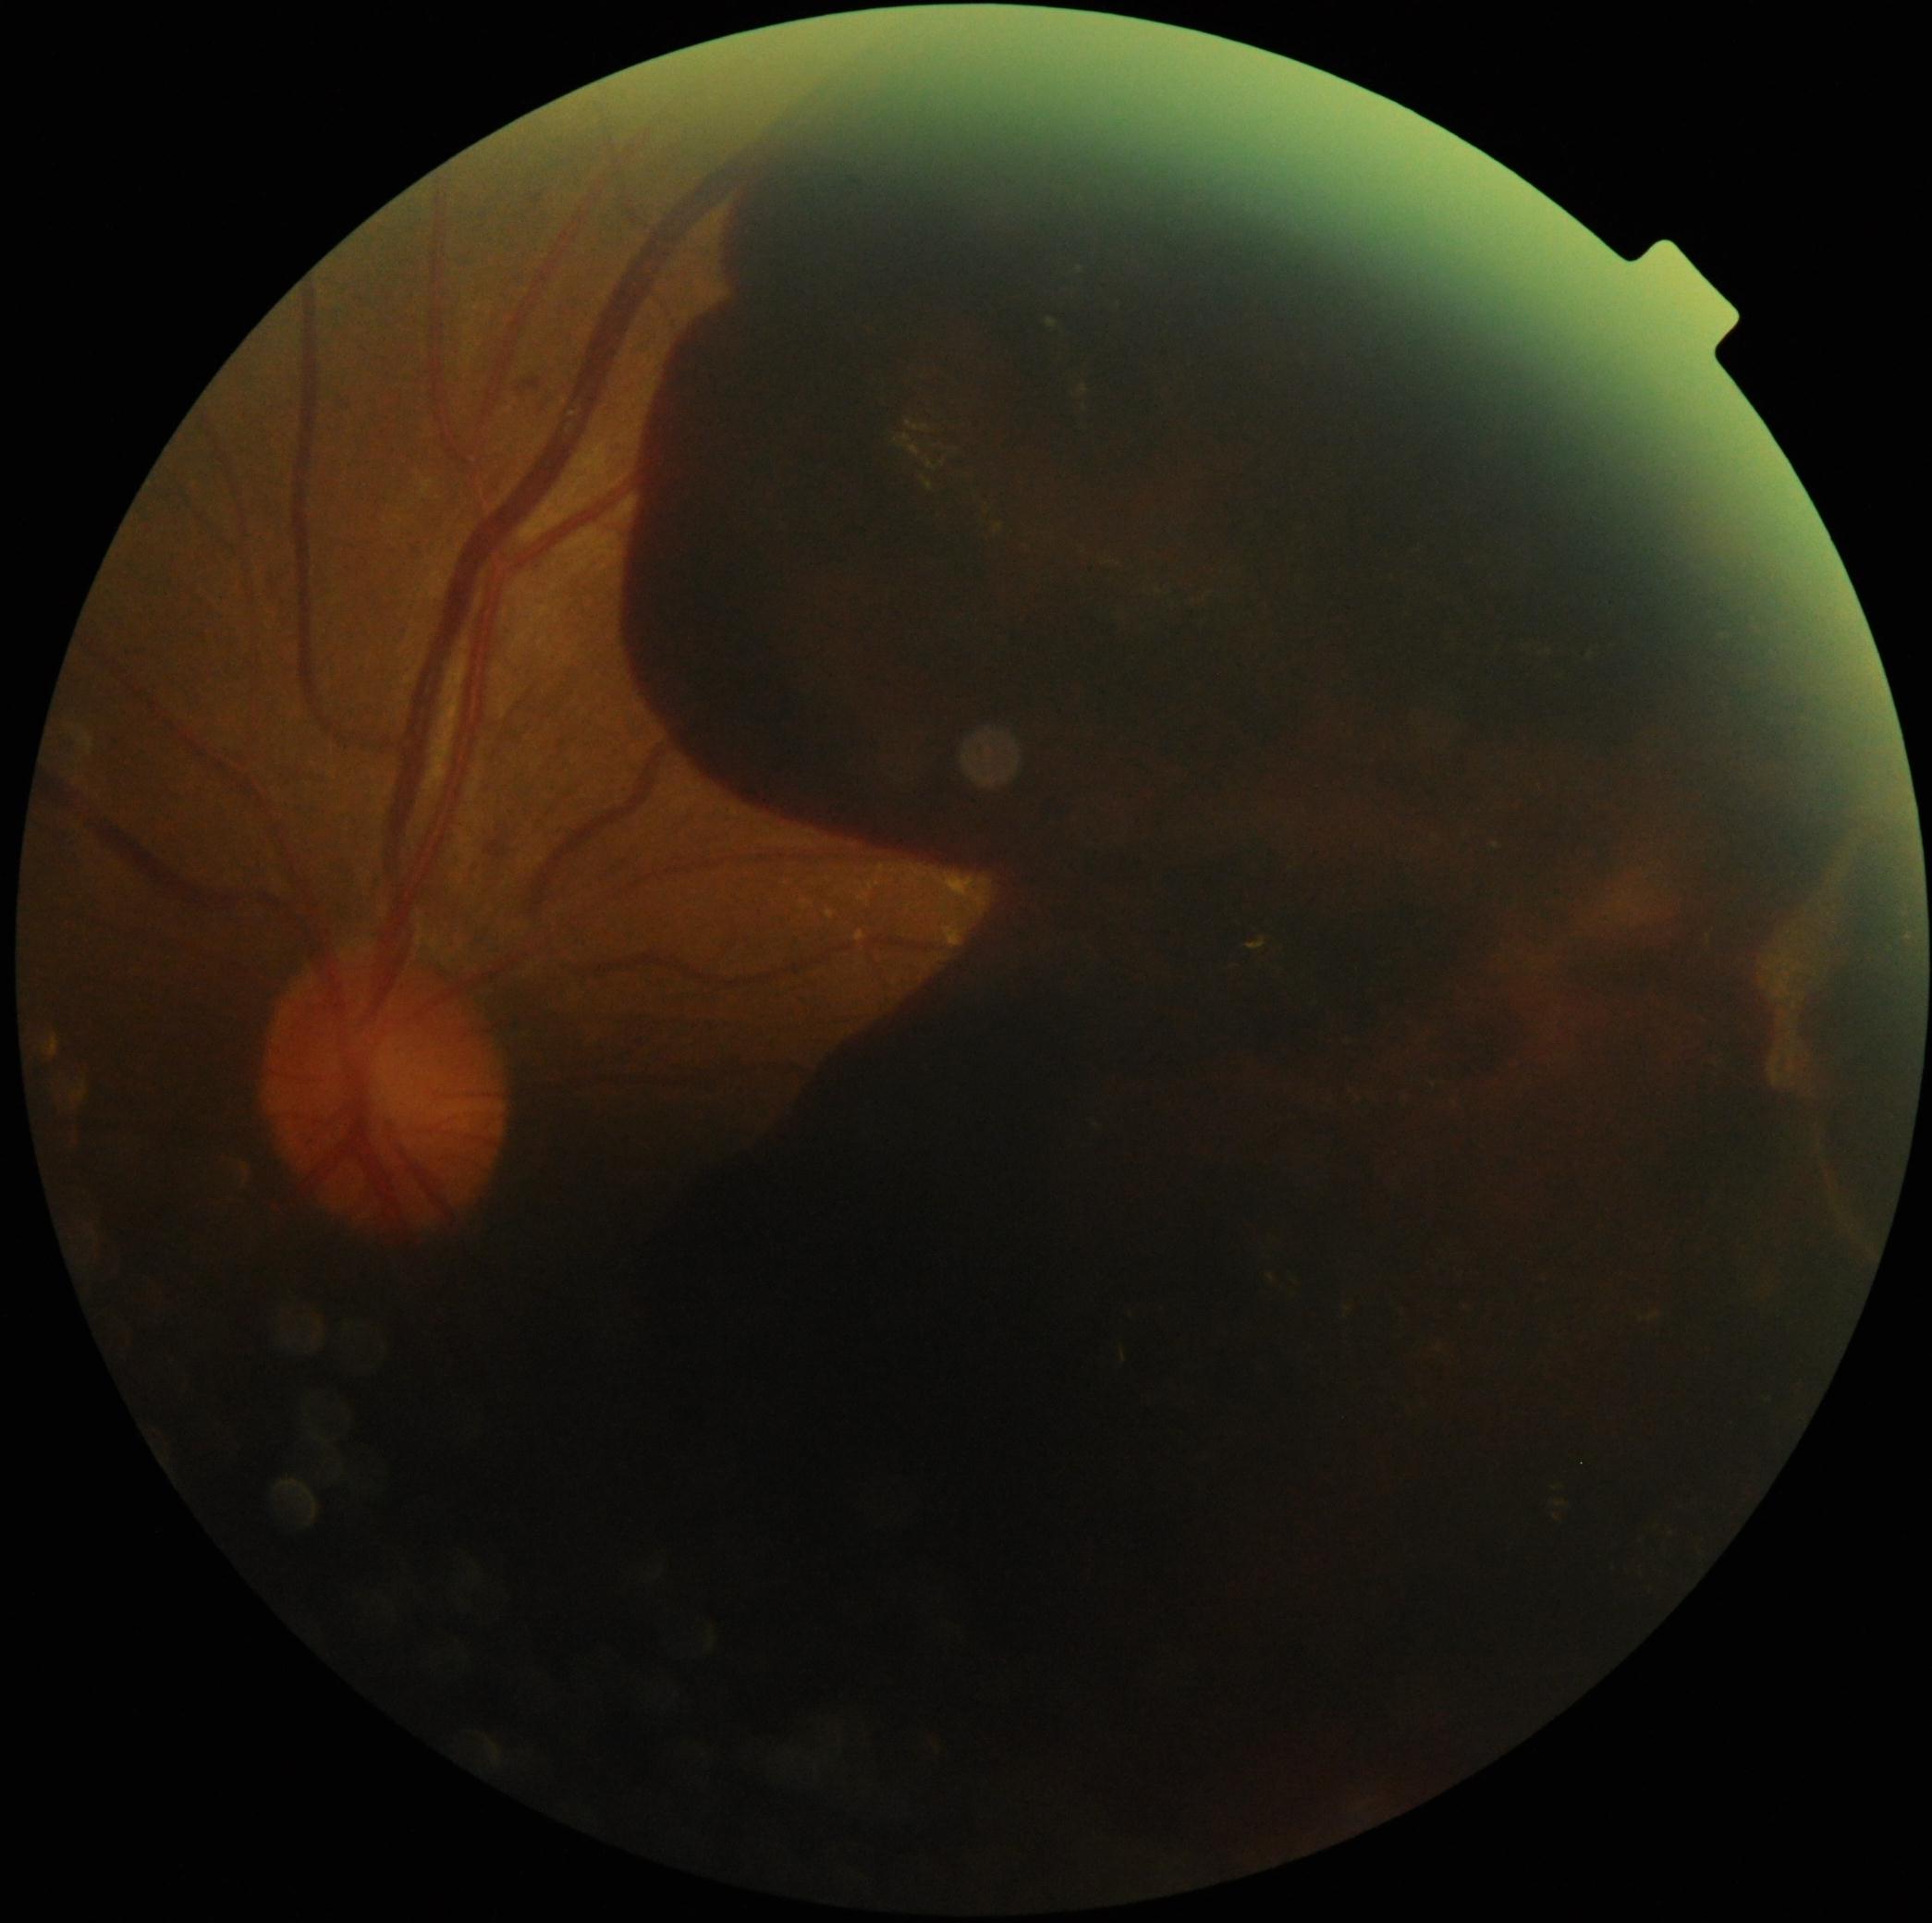
{
  "dr_grade": "grade 4 (PDR)"
}